Posterior pole color fundus photograph, camera: NIDEK AFC-230, 45-degree field of view, no pharmacologic dilation — 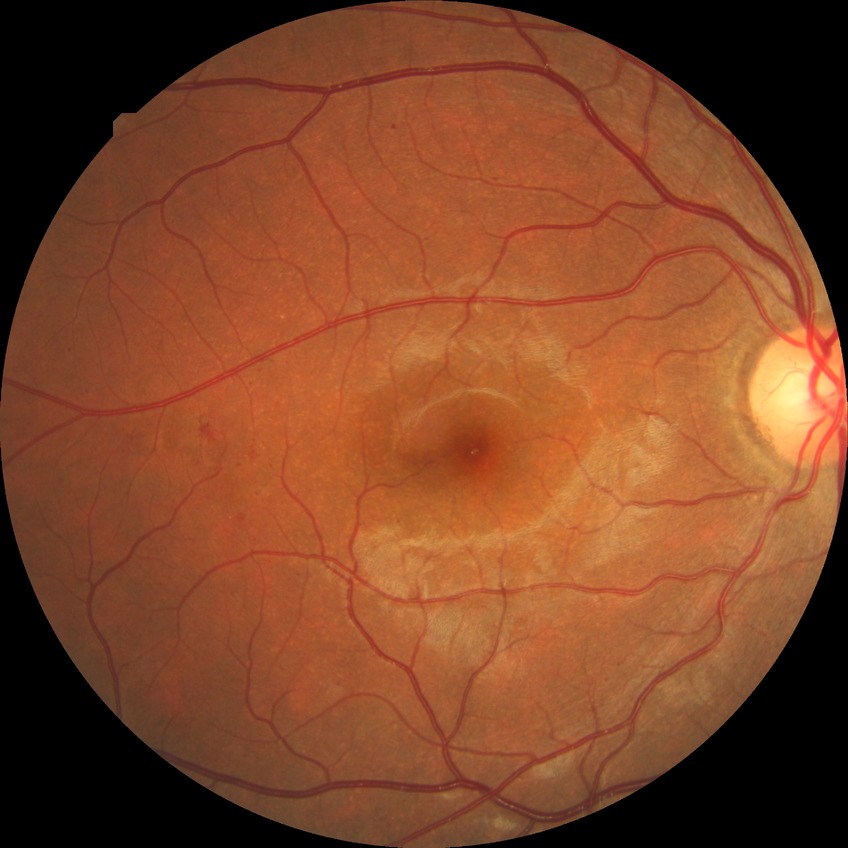 Diabetic retinopathy severity: simple diabetic retinopathy.